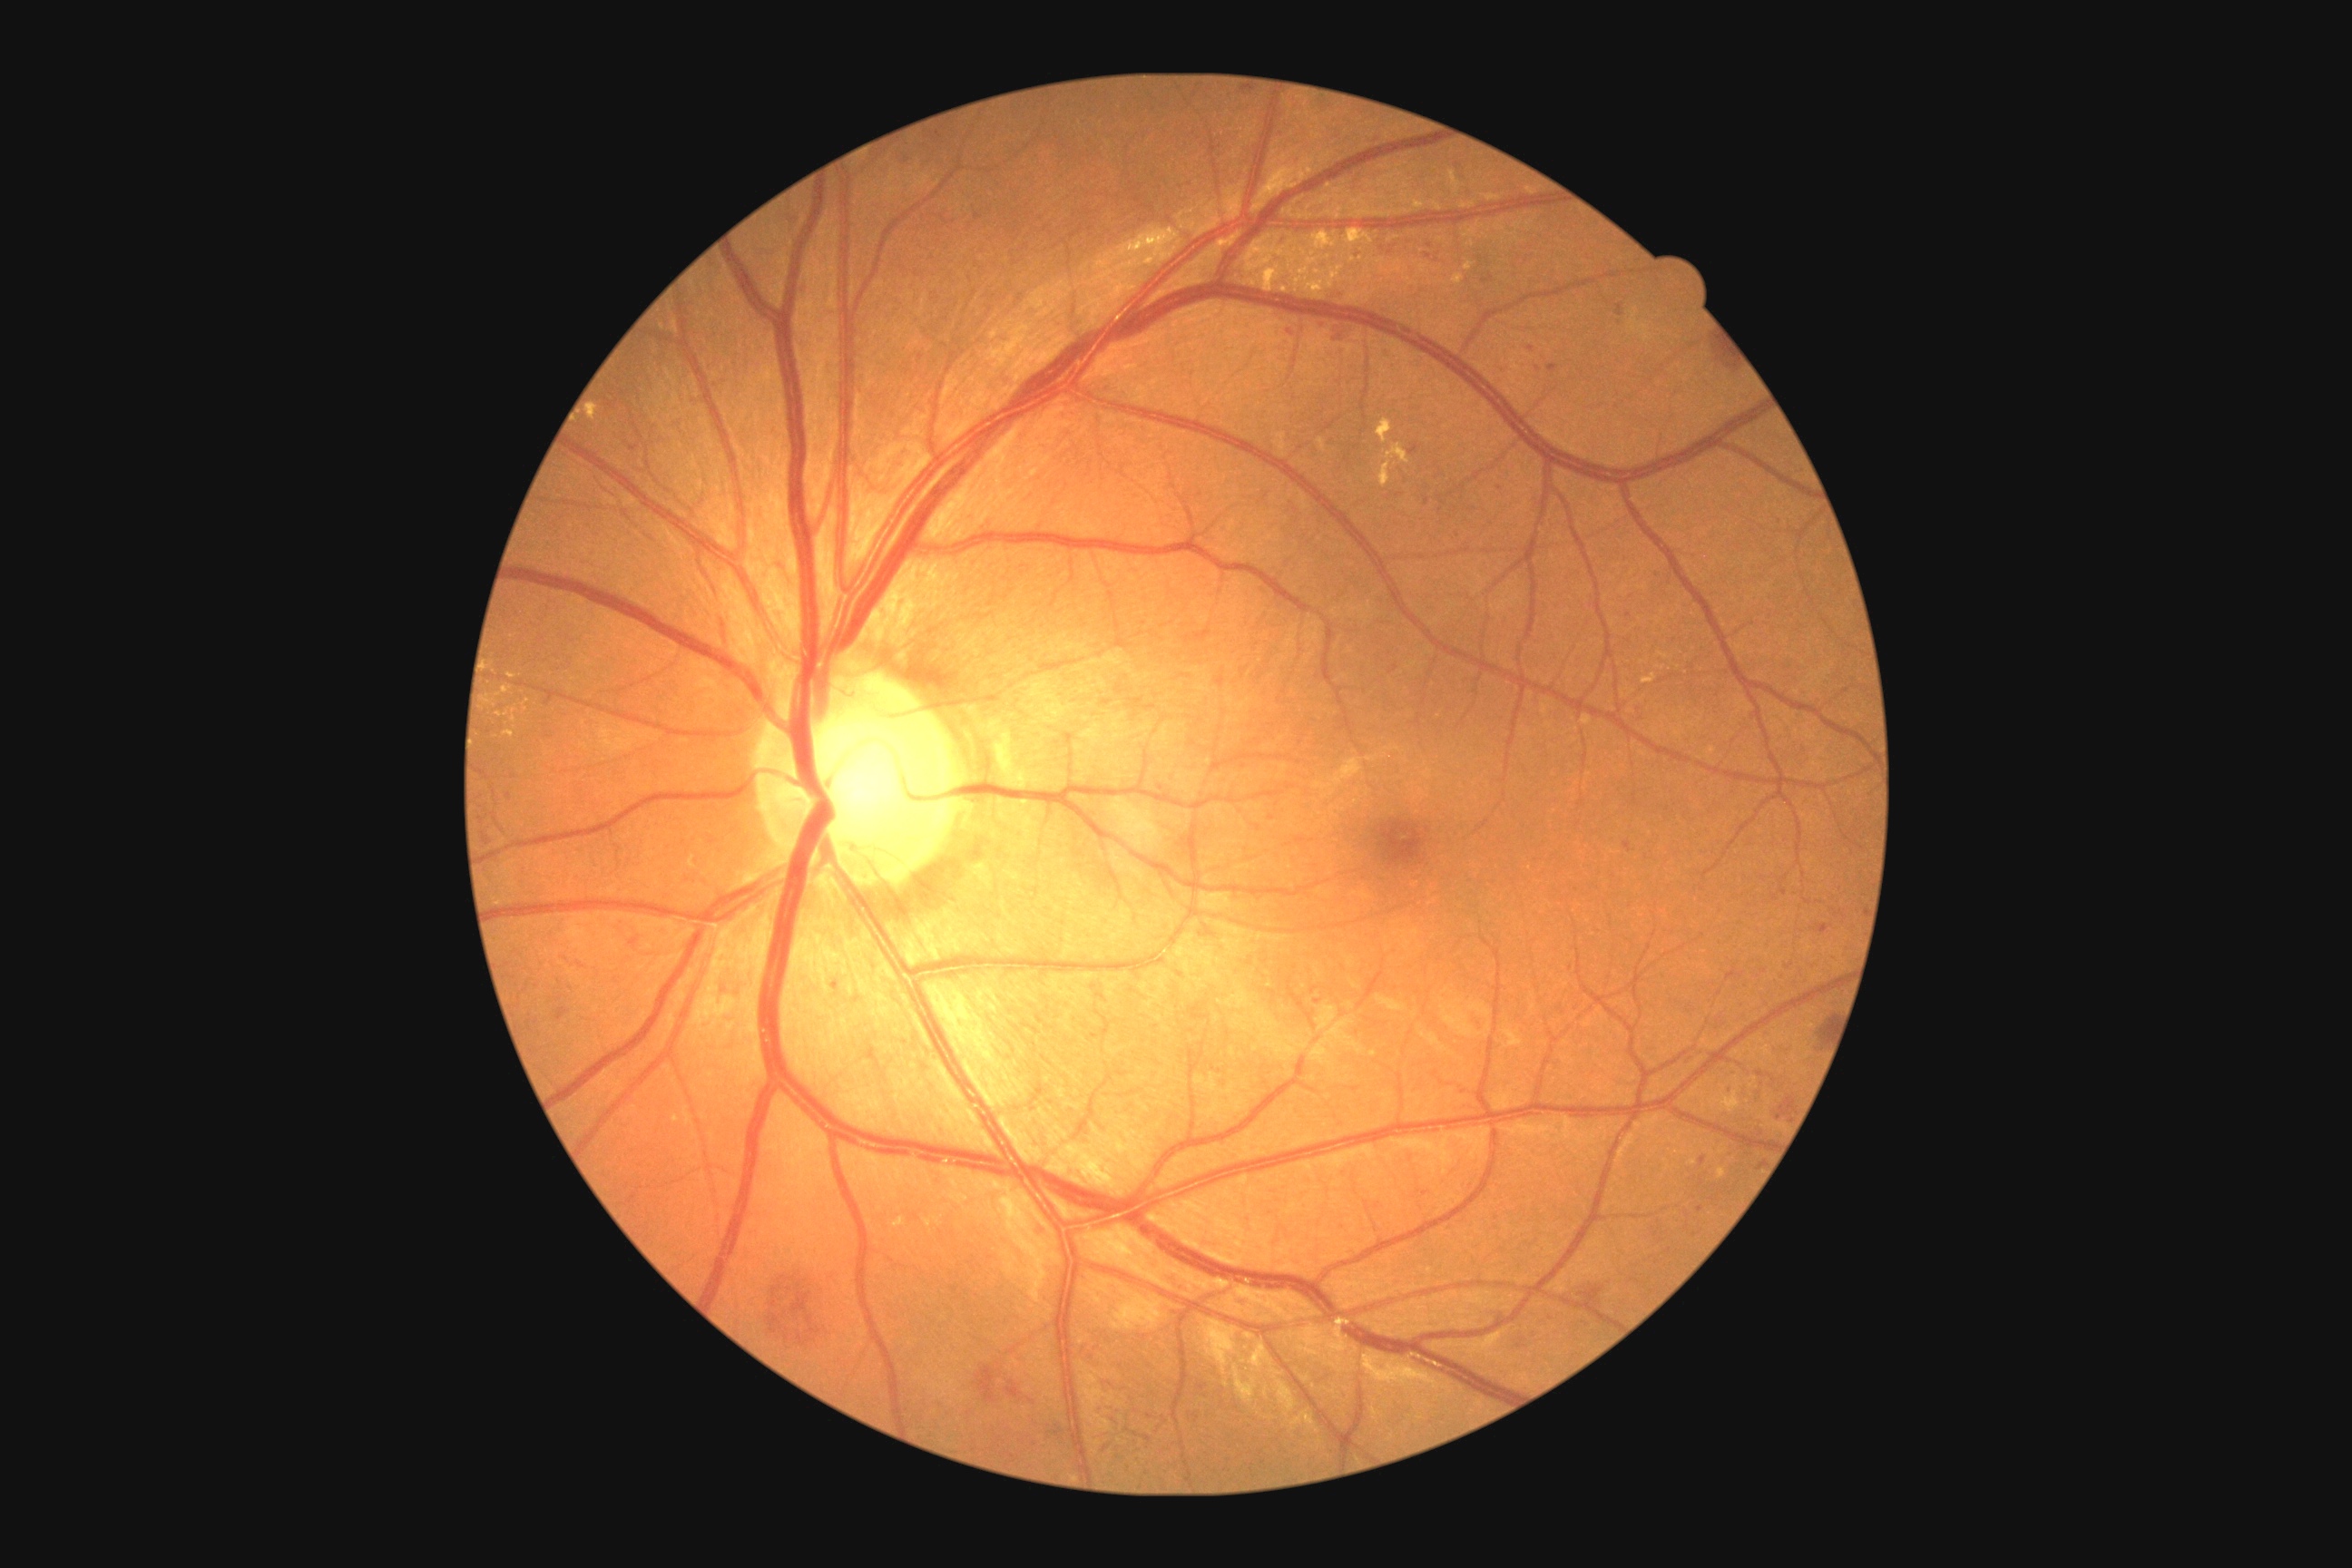

partial: true
dr_grade: 3
dr_grade_name: severe NPDR
lesions:
  he:
    - l=1447, t=529, r=1462, b=540
    - l=1235, t=90, r=1259, b=95
    - l=798, t=280, r=810, b=297
    - l=1710, t=1008, r=1729, b=1030
    - l=1627, t=591, r=1638, b=598
    - l=1533, t=364, r=1542, b=373
    - l=1707, t=333, r=1738, b=373
    - l=1389, t=362, r=1398, b=369
    - l=1761, t=1024, r=1776, b=1037
    - l=1752, t=1079, r=1765, b=1104
    - l=1783, t=1021, r=1792, b=1028
    - l=1625, t=609, r=1634, b=620
    - l=1331, t=324, r=1360, b=344
    - l=1217, t=1079, r=1228, b=1088
  he_small:
    - point(1784, 893)
    - point(1743, 1006)
    - point(1477, 476)
  ex:
    - l=1453, t=173, r=1456, b=181
    - l=1344, t=761, r=1360, b=776
    - l=1524, t=186, r=1540, b=197
    - l=1260, t=170, r=1289, b=197
    - l=589, t=406, r=598, b=418
    - l=1727, t=1099, r=1740, b=1108
    - l=1146, t=259, r=1155, b=264
    - l=1315, t=231, r=1331, b=248
  ex_small:
    - point(707, 1014)
    - point(1722, 1173)
    - point(1389, 454)
    - point(1267, 262)
    - point(1361, 250)
    - point(1586, 721)
    - point(899, 1223)